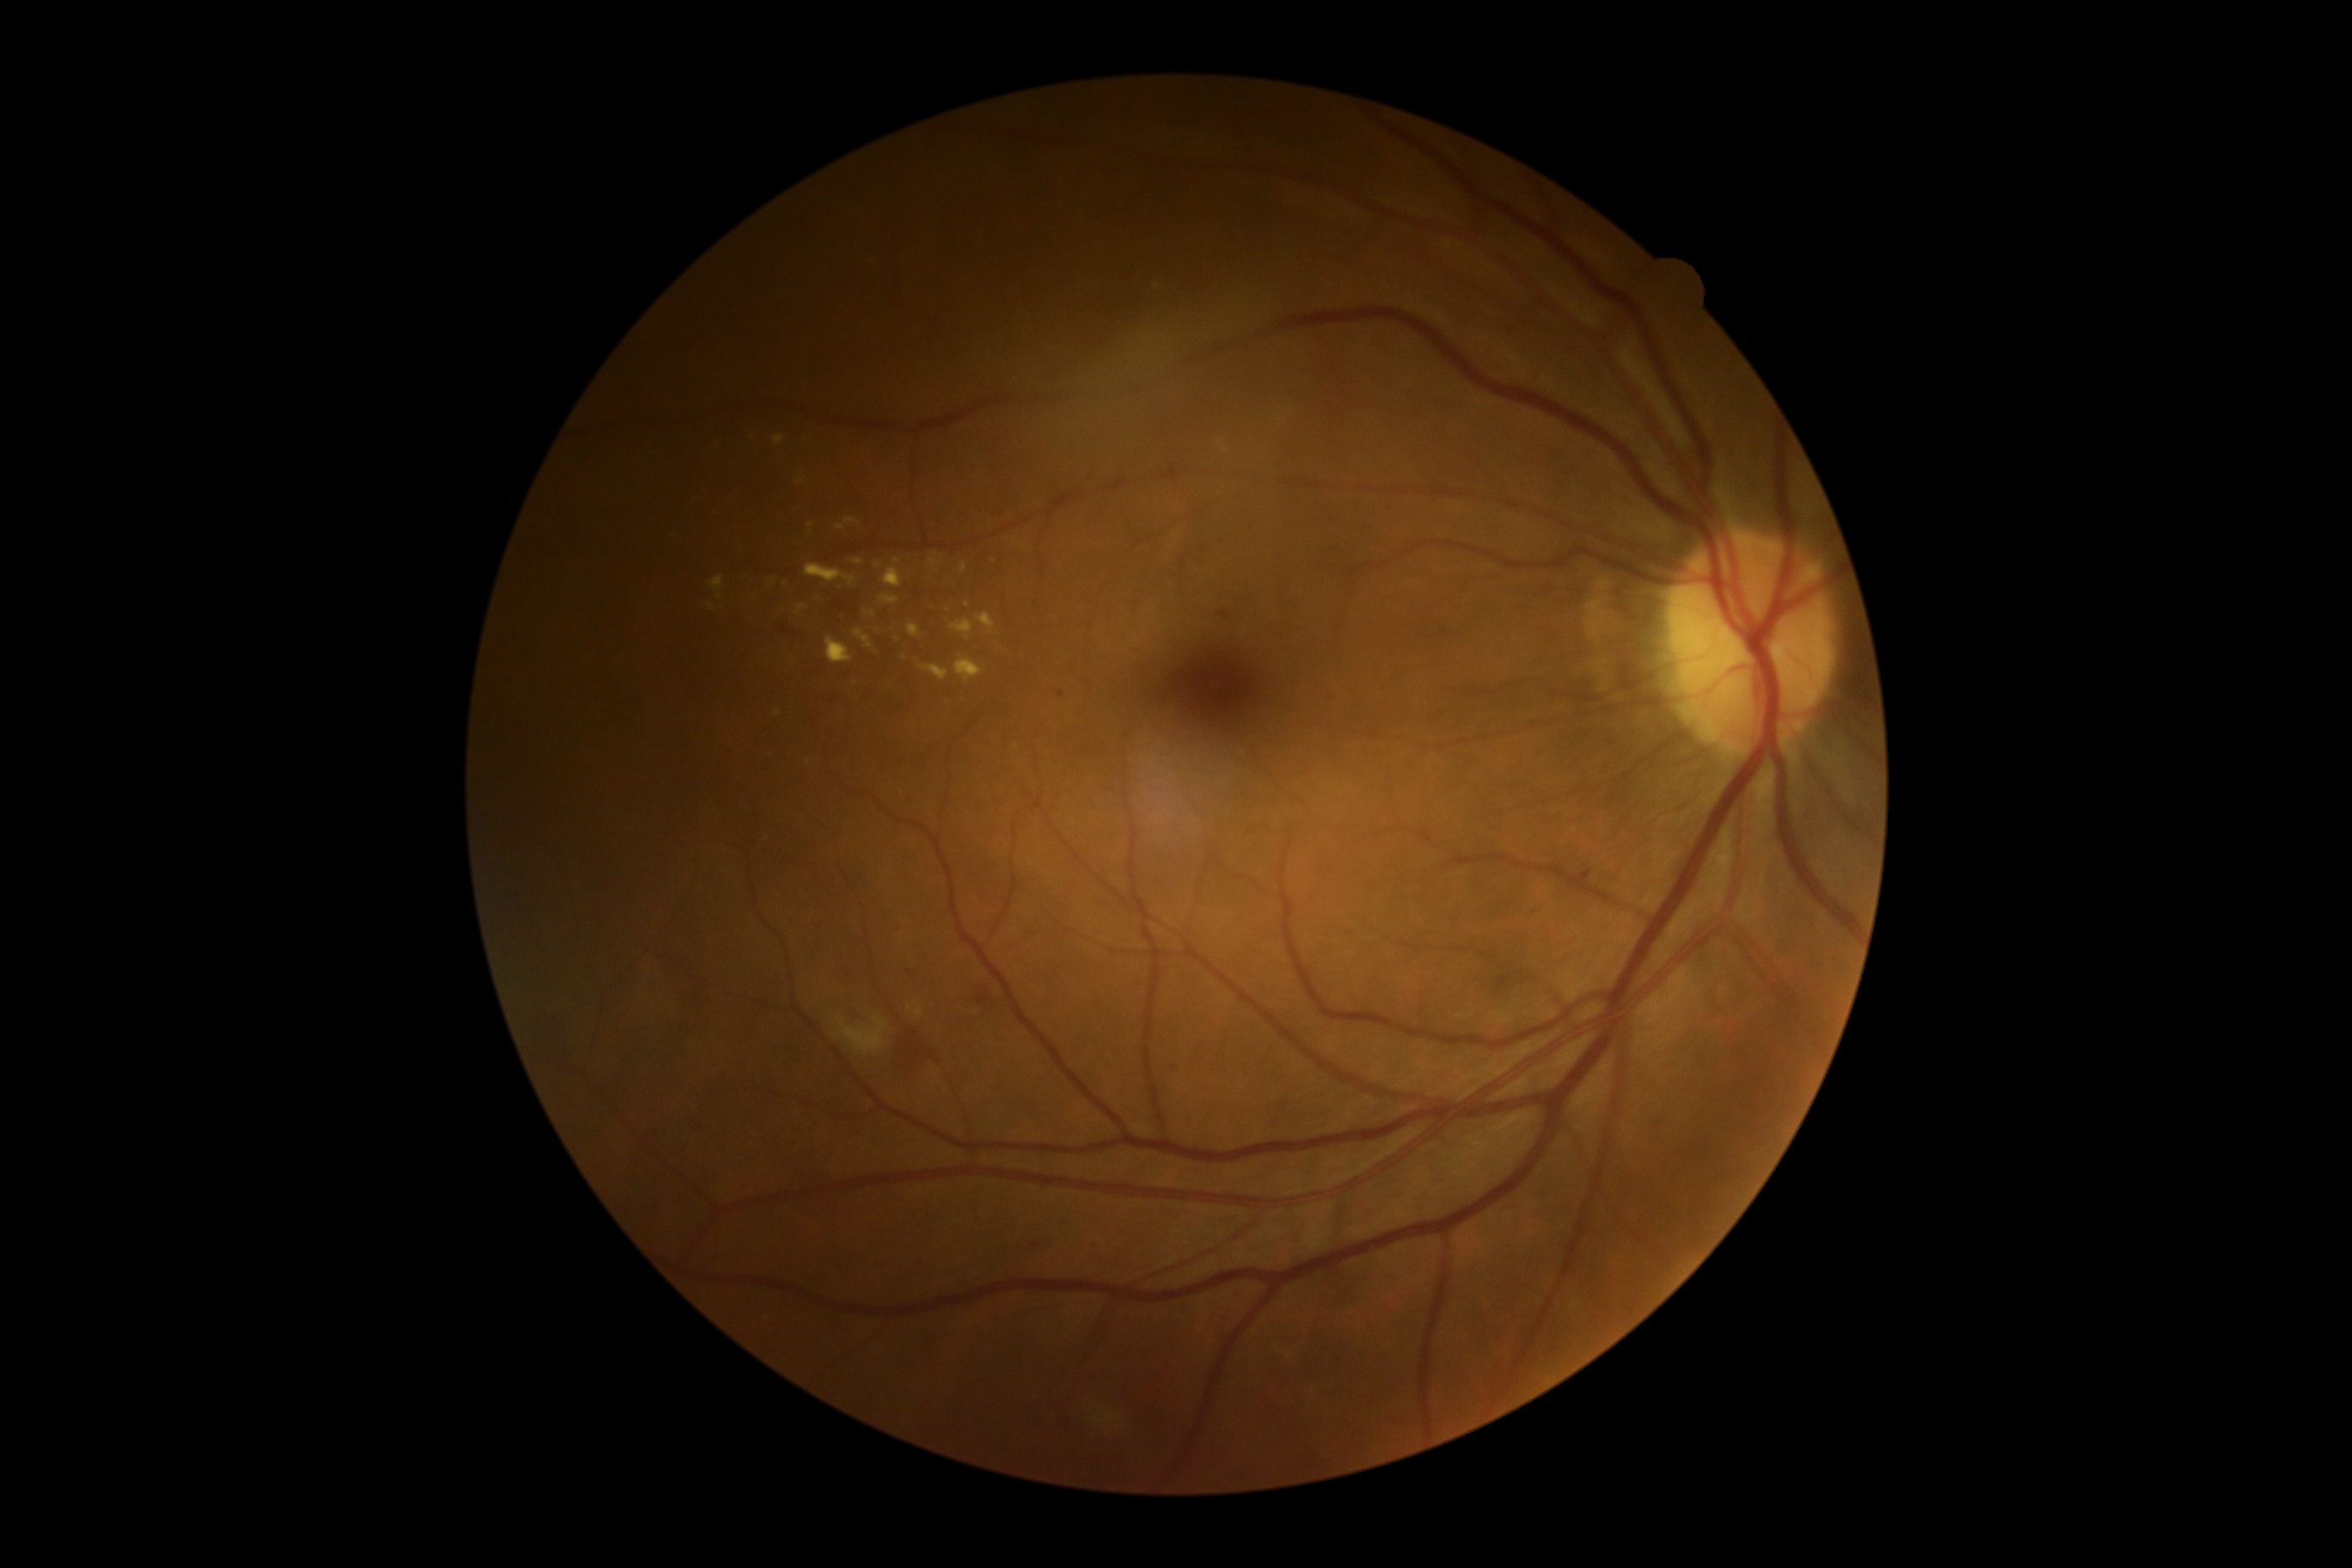

<lesions partial="true">
  <dr_grade>2</dr_grade>
  <se>[835, 1015, 886, 1057]</se>
  <se_small_approx>point(835, 1036)</se_small_approx>
  <ma>[1581, 874, 1589, 881]; [1172, 1067, 1179, 1079]; [1497, 976, 1510, 991]; [1325, 692, 1333, 701]</ma>
  <ma_small_approx>point(901, 929); point(1349, 932); point(910, 972); point(1035, 1245); point(1061, 695)</ma_small_approx>
  <ex partial="true">[775, 436, 785, 446]; [805, 565, 857, 587]; [909, 625, 921, 639]; [919, 665, 950, 682]; [916, 1007, 924, 1017]; [883, 568, 902, 589]; [836, 525, 845, 530]</ex>
  <ex_small_approx>point(771, 754); point(936, 570); point(840, 589); point(878, 565); point(752, 438); point(876, 632); point(720, 598); point(950, 701); point(818, 600)</ex_small_approx>
  <he>[974, 986, 989, 1003]; [1220, 611, 1228, 620]; [848, 1012, 862, 1020]; [778, 623, 795, 637]; [897, 1038, 933, 1072]</he>
</lesions>